Wide-field contact fundus photograph of an infant
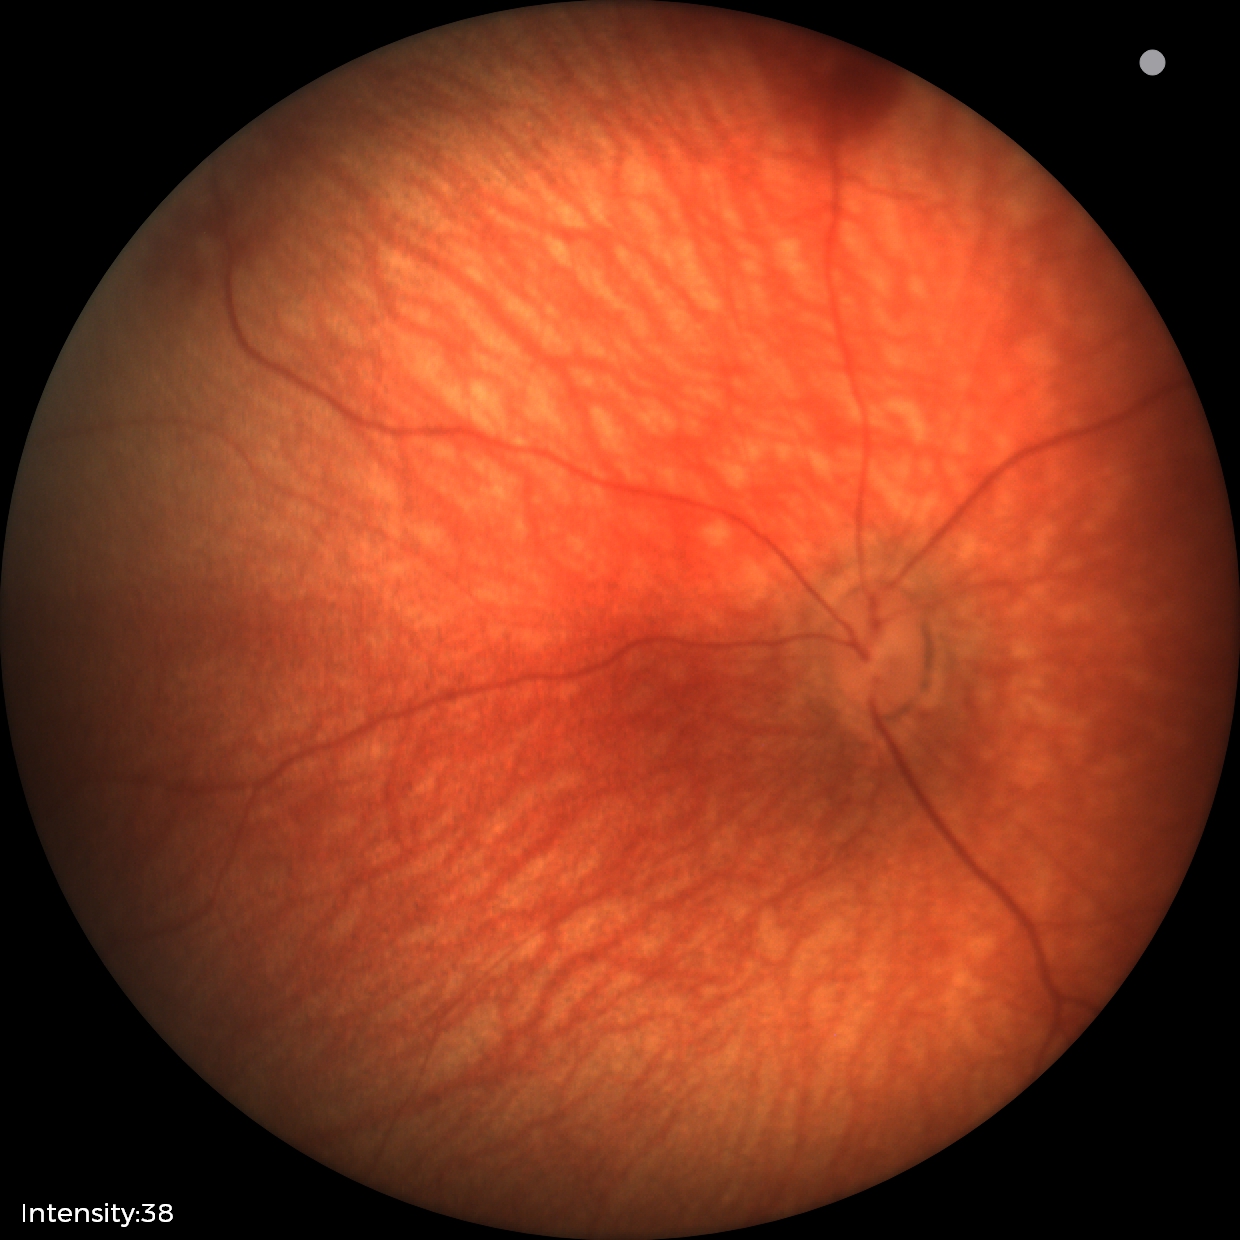
Screening diagnosis: retinal hemorrhages.